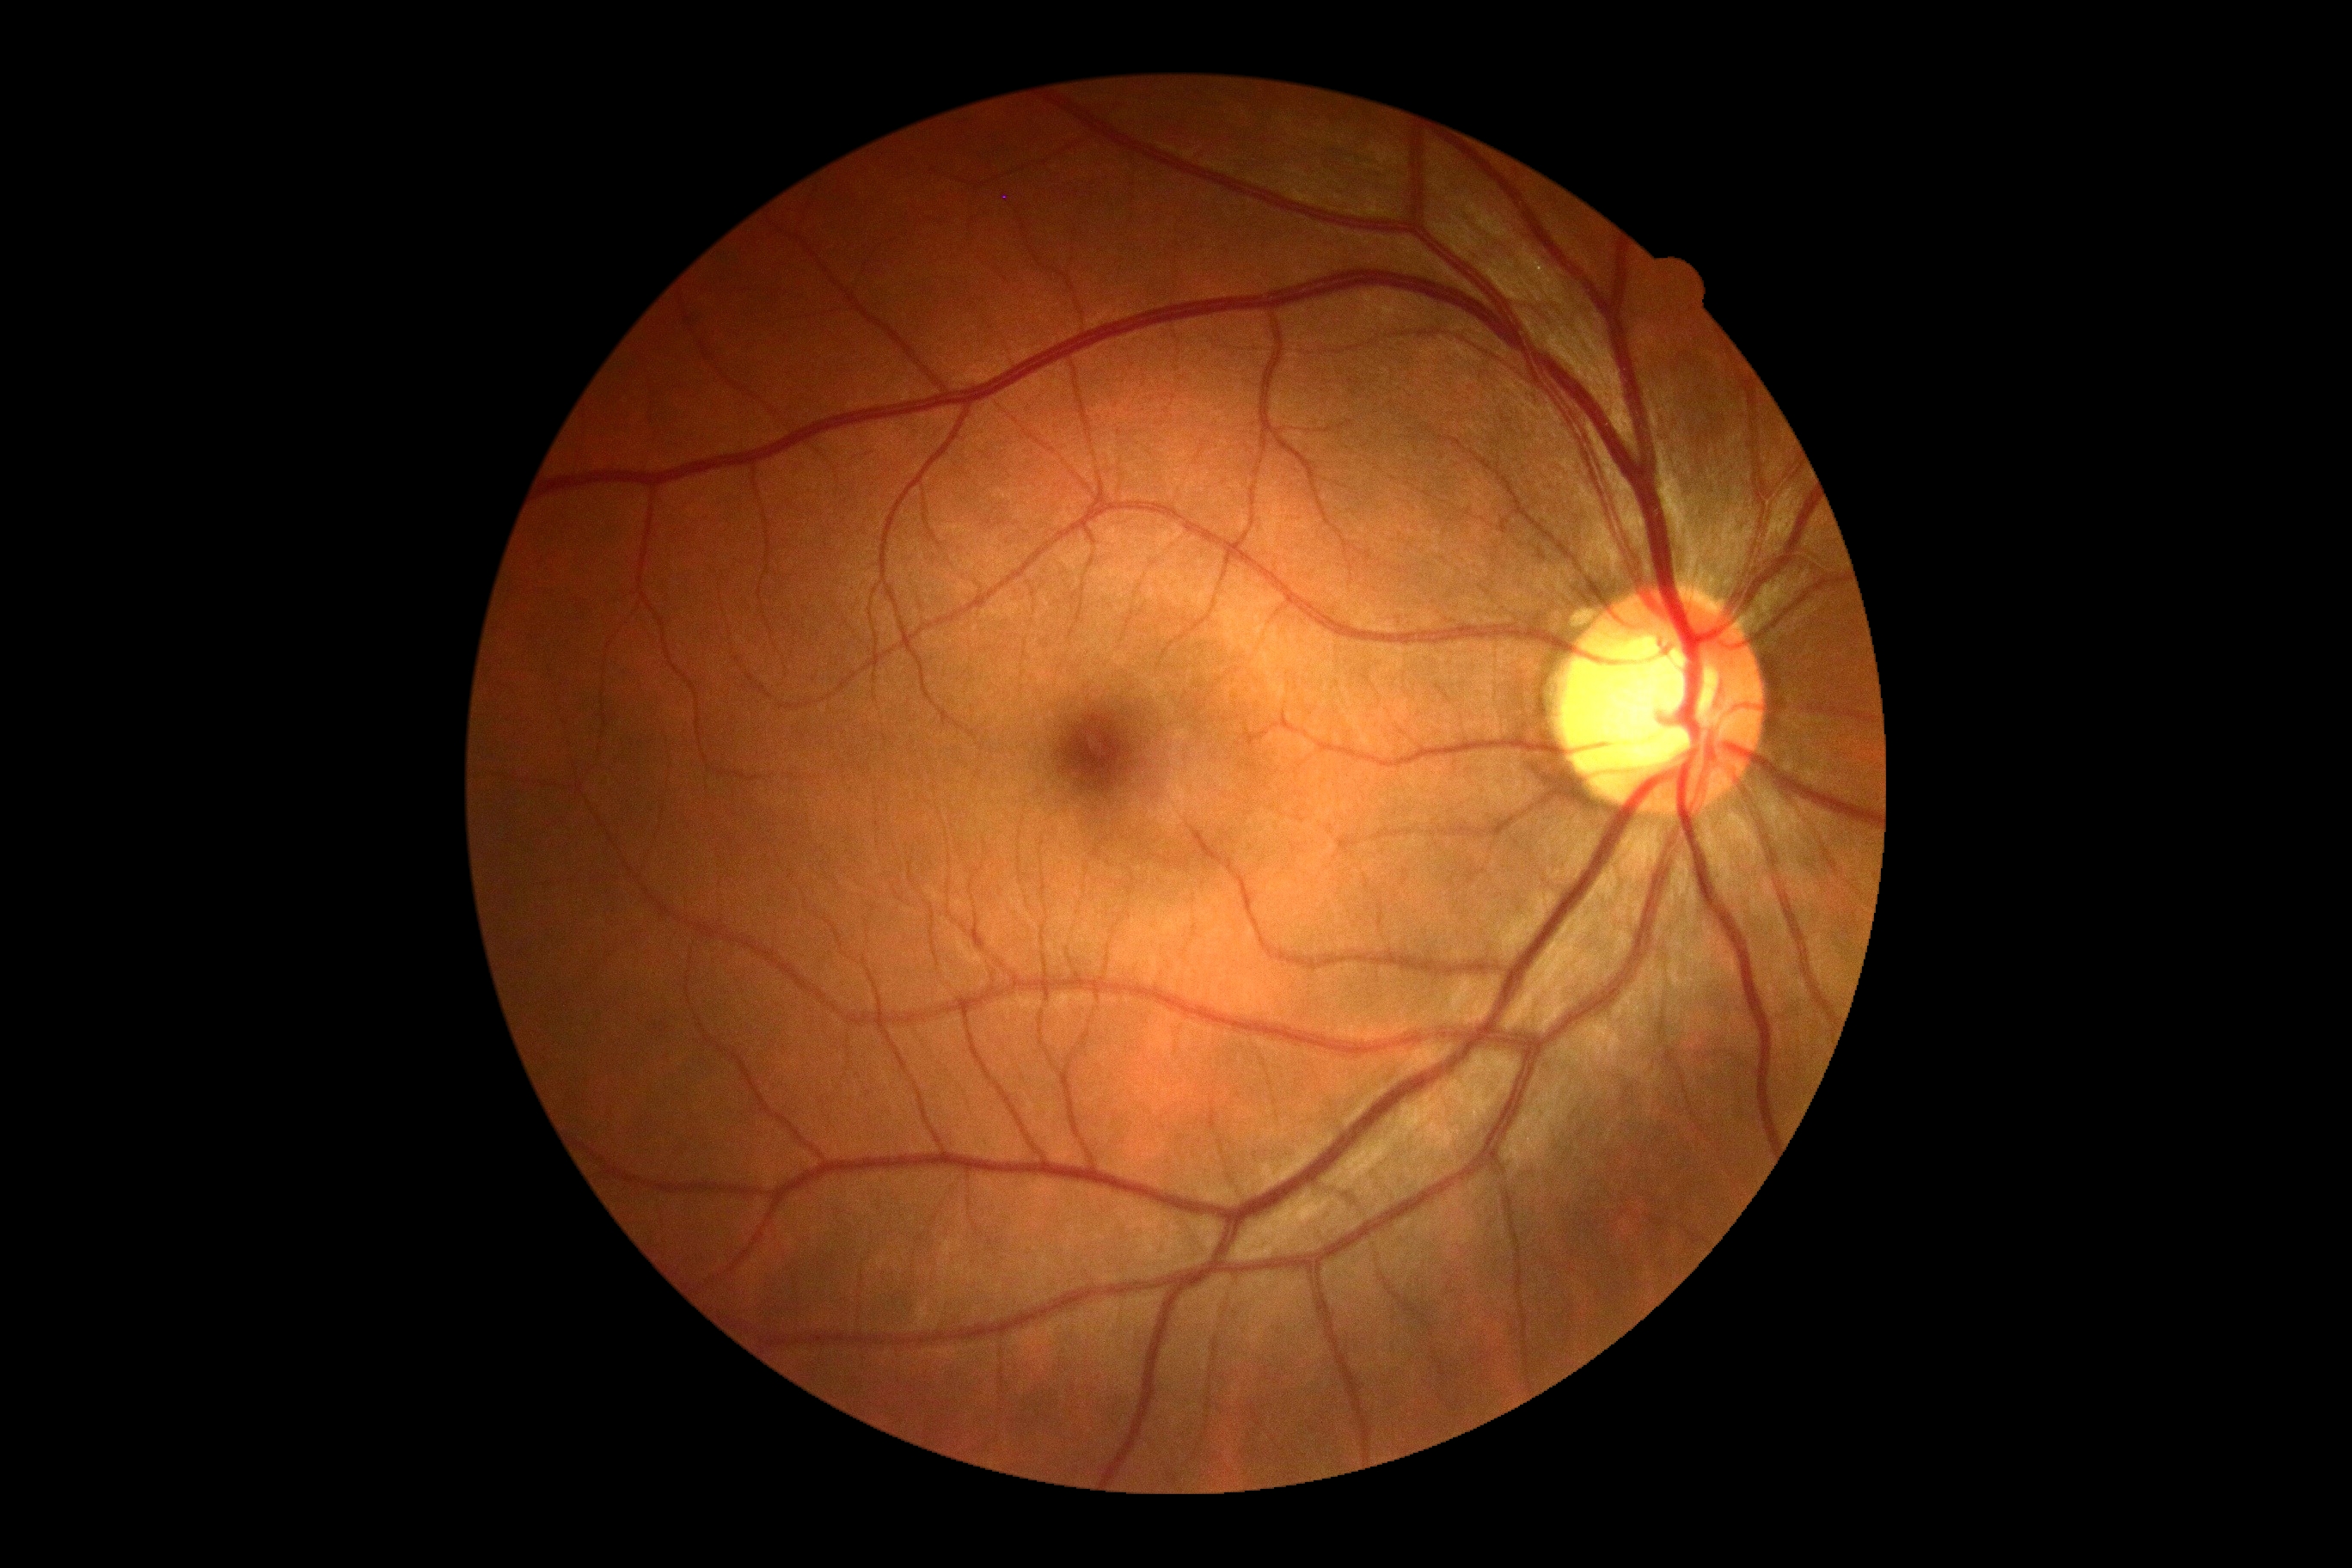

Retinopathy is 0.